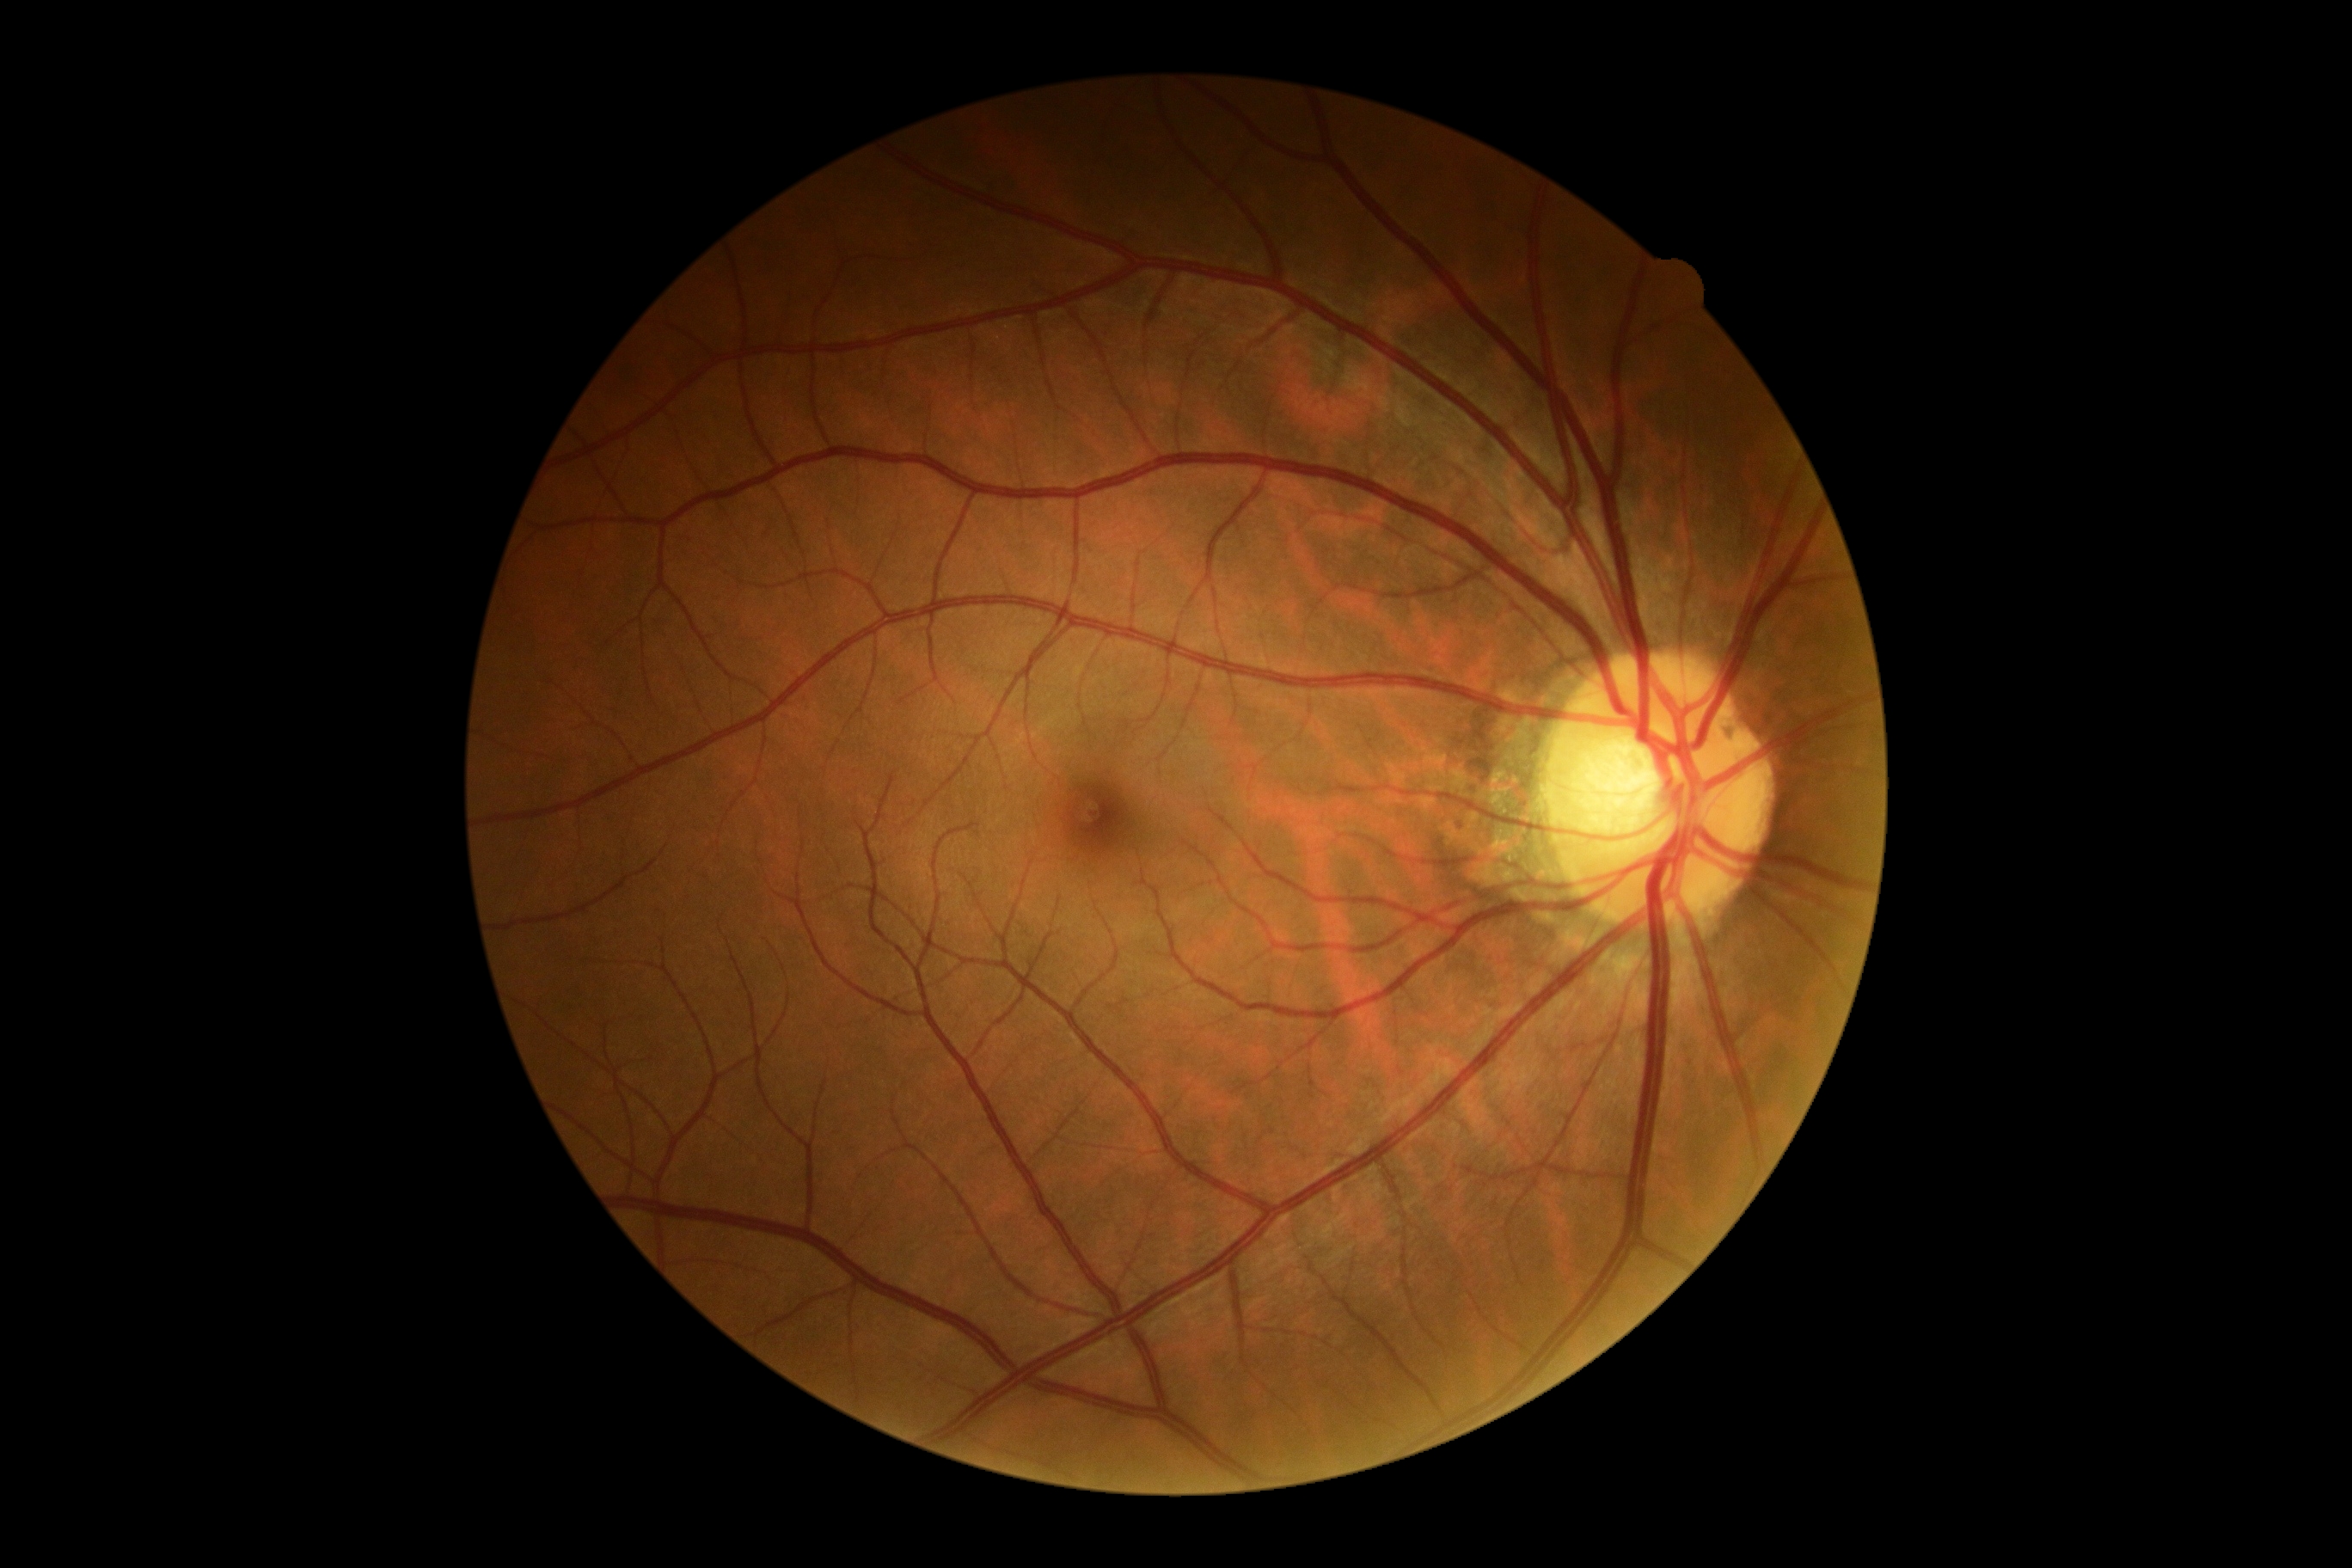 No apparent diabetic retinopathy. DR severity is grade 0 (no apparent retinopathy).